Wide-field fundus photograph from neonatal ROP screening:
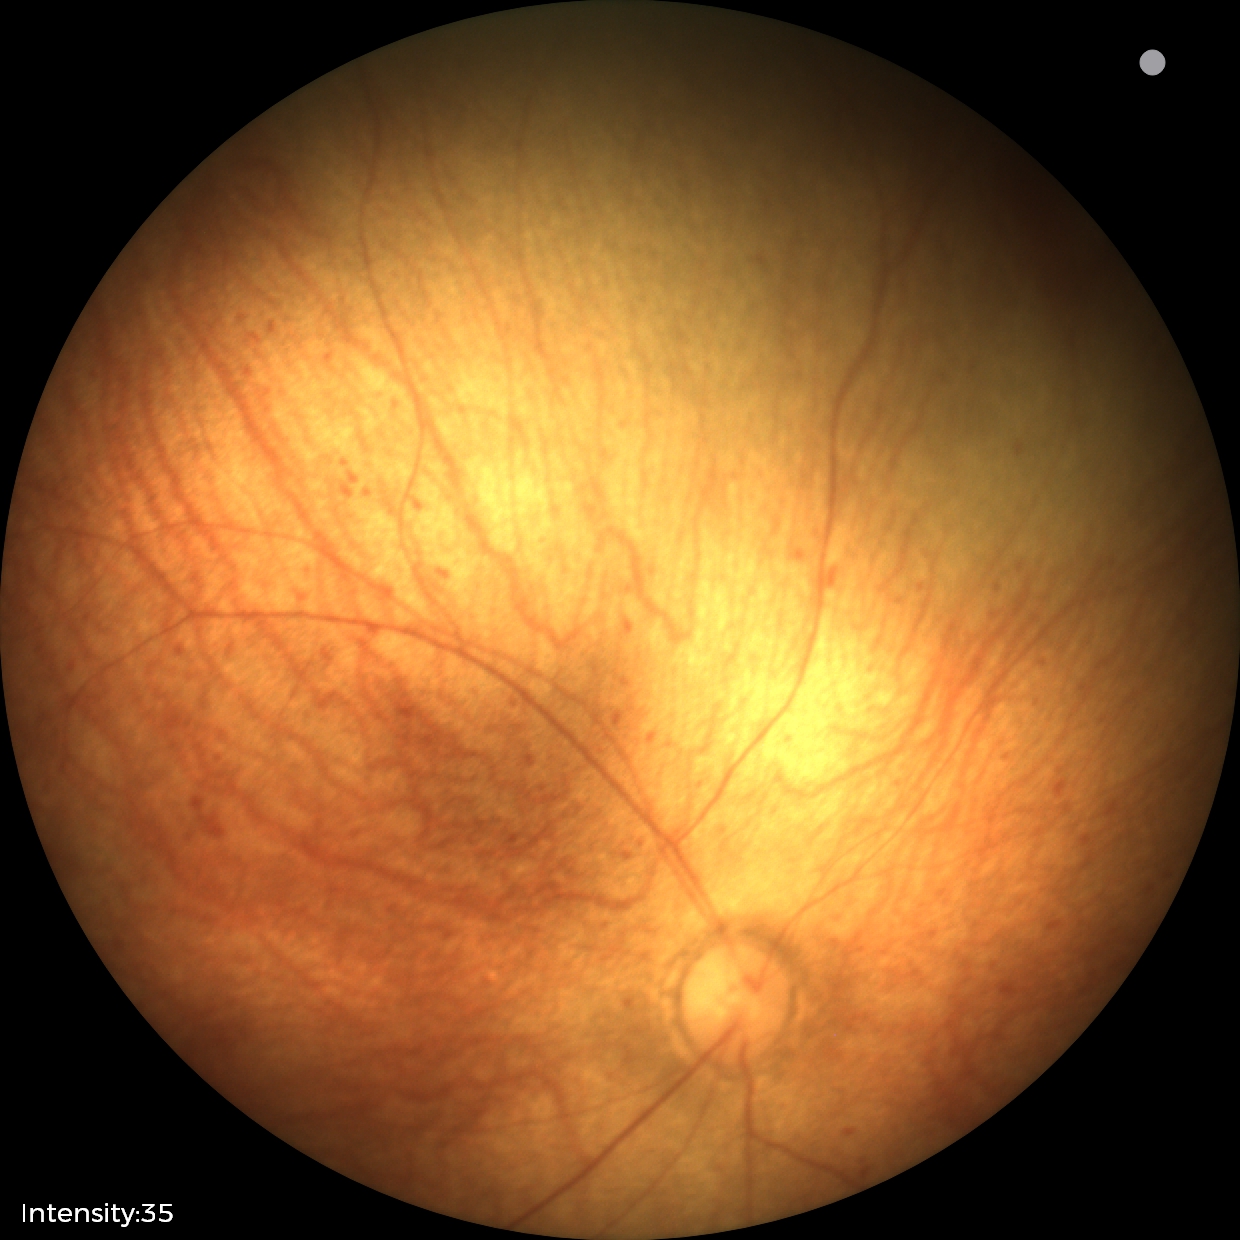
Screening examination diagnosed as physiological.